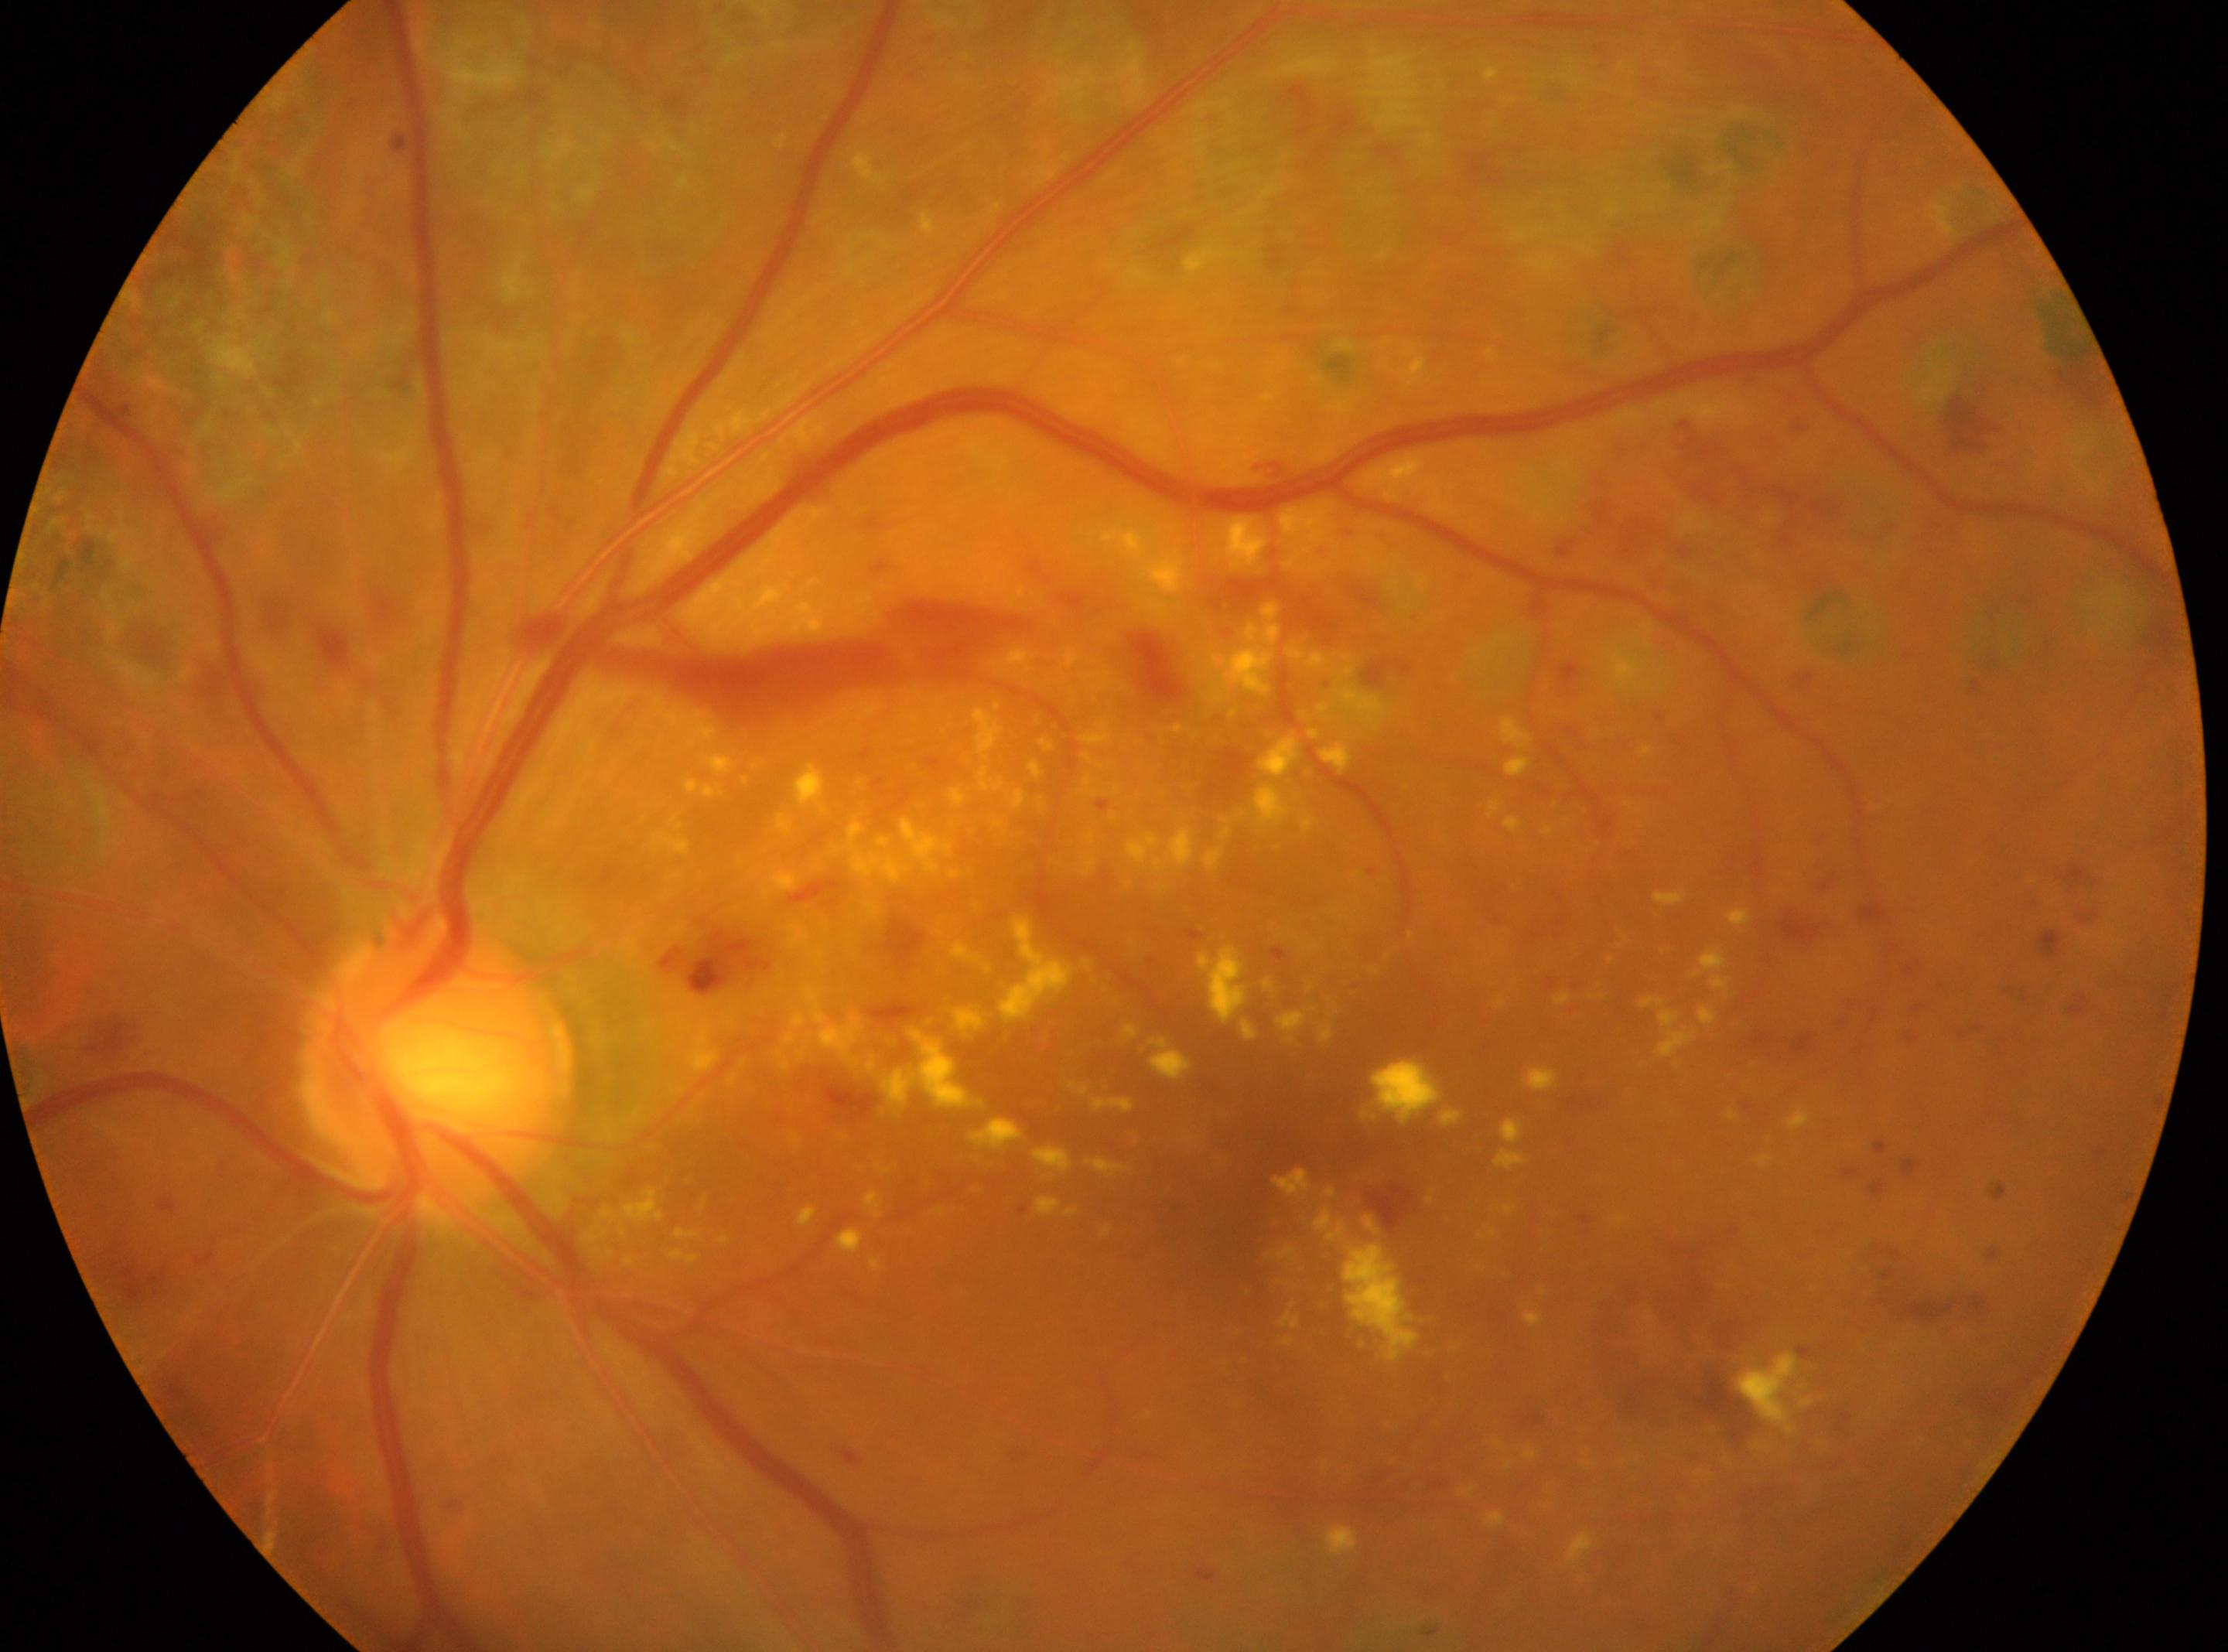

This is the left eye. Fovea centralis located at 1247, 1166. Diabetic retinopathy severity: DR with laser photocoagulation scars, reclassified as PDR (grade 4). Disc center: 437, 1064.